Acquired with a NIDEK AFC-230. Diabetic retinopathy graded by the modified Davis classification. 848 by 848 pixels:
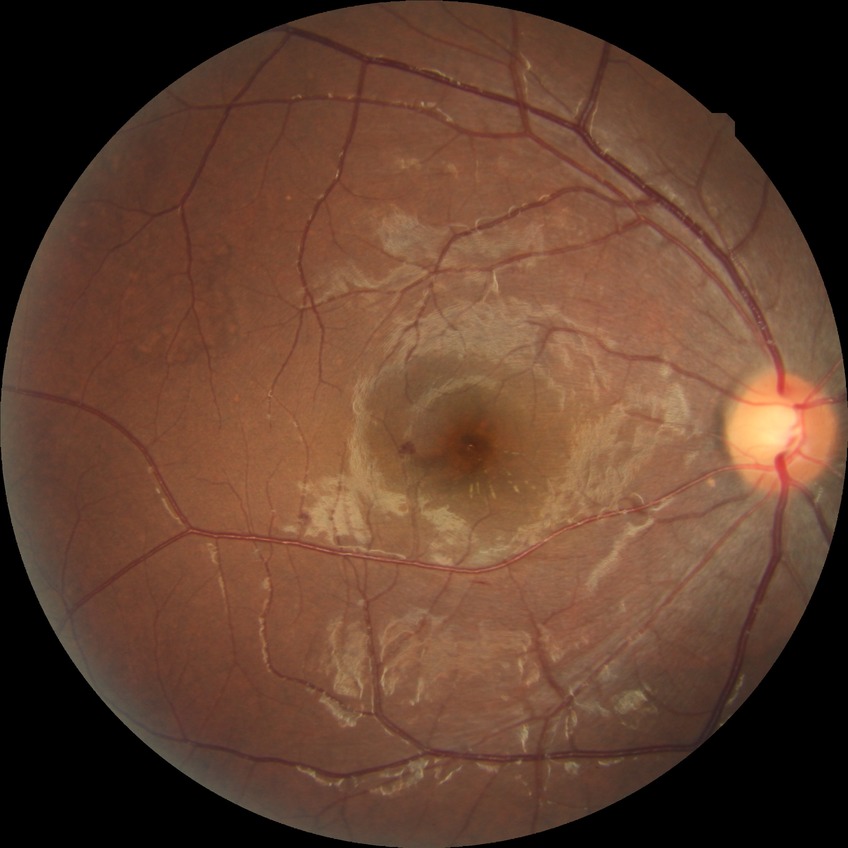

Diabetic retinopathy (DR) is simple diabetic retinopathy (SDR).